NIDEK AFC-230; 848x848; posterior pole photograph; no pharmacologic dilation; FOV: 45 degrees; diabetic retinopathy graded by the modified Davis classification
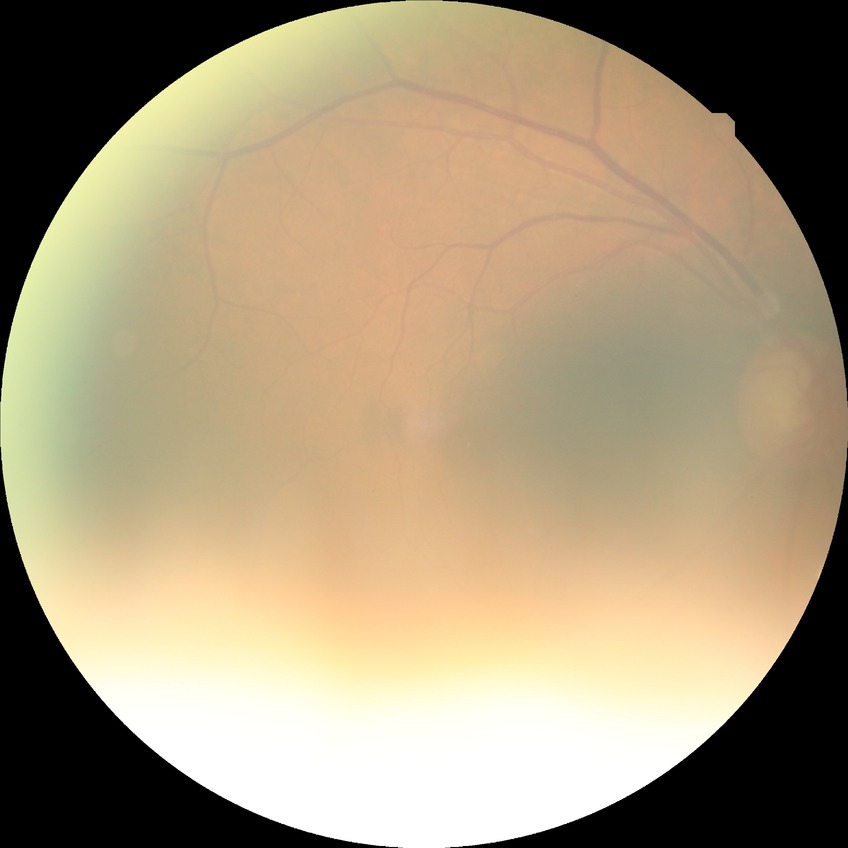
Assessment:
- diabetic retinopathy stage: no diabetic retinopathy